Acquired with a NIDEK AFC-230. Image size 848x848. Modified Davis grading.
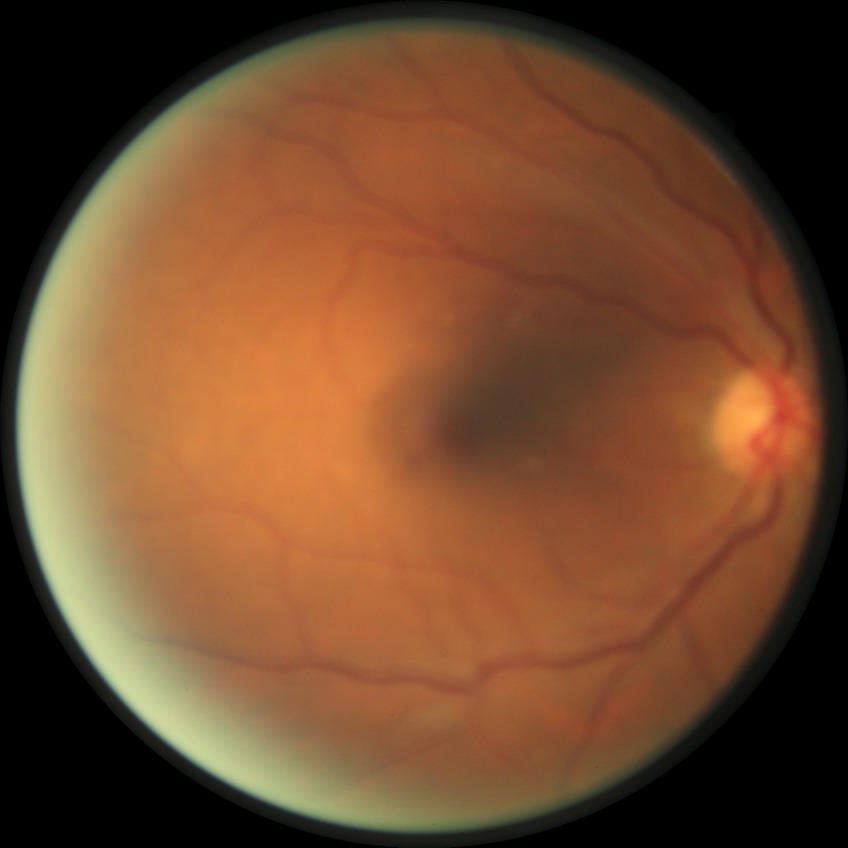 DR is NDR.